UWF retinal mosaic.
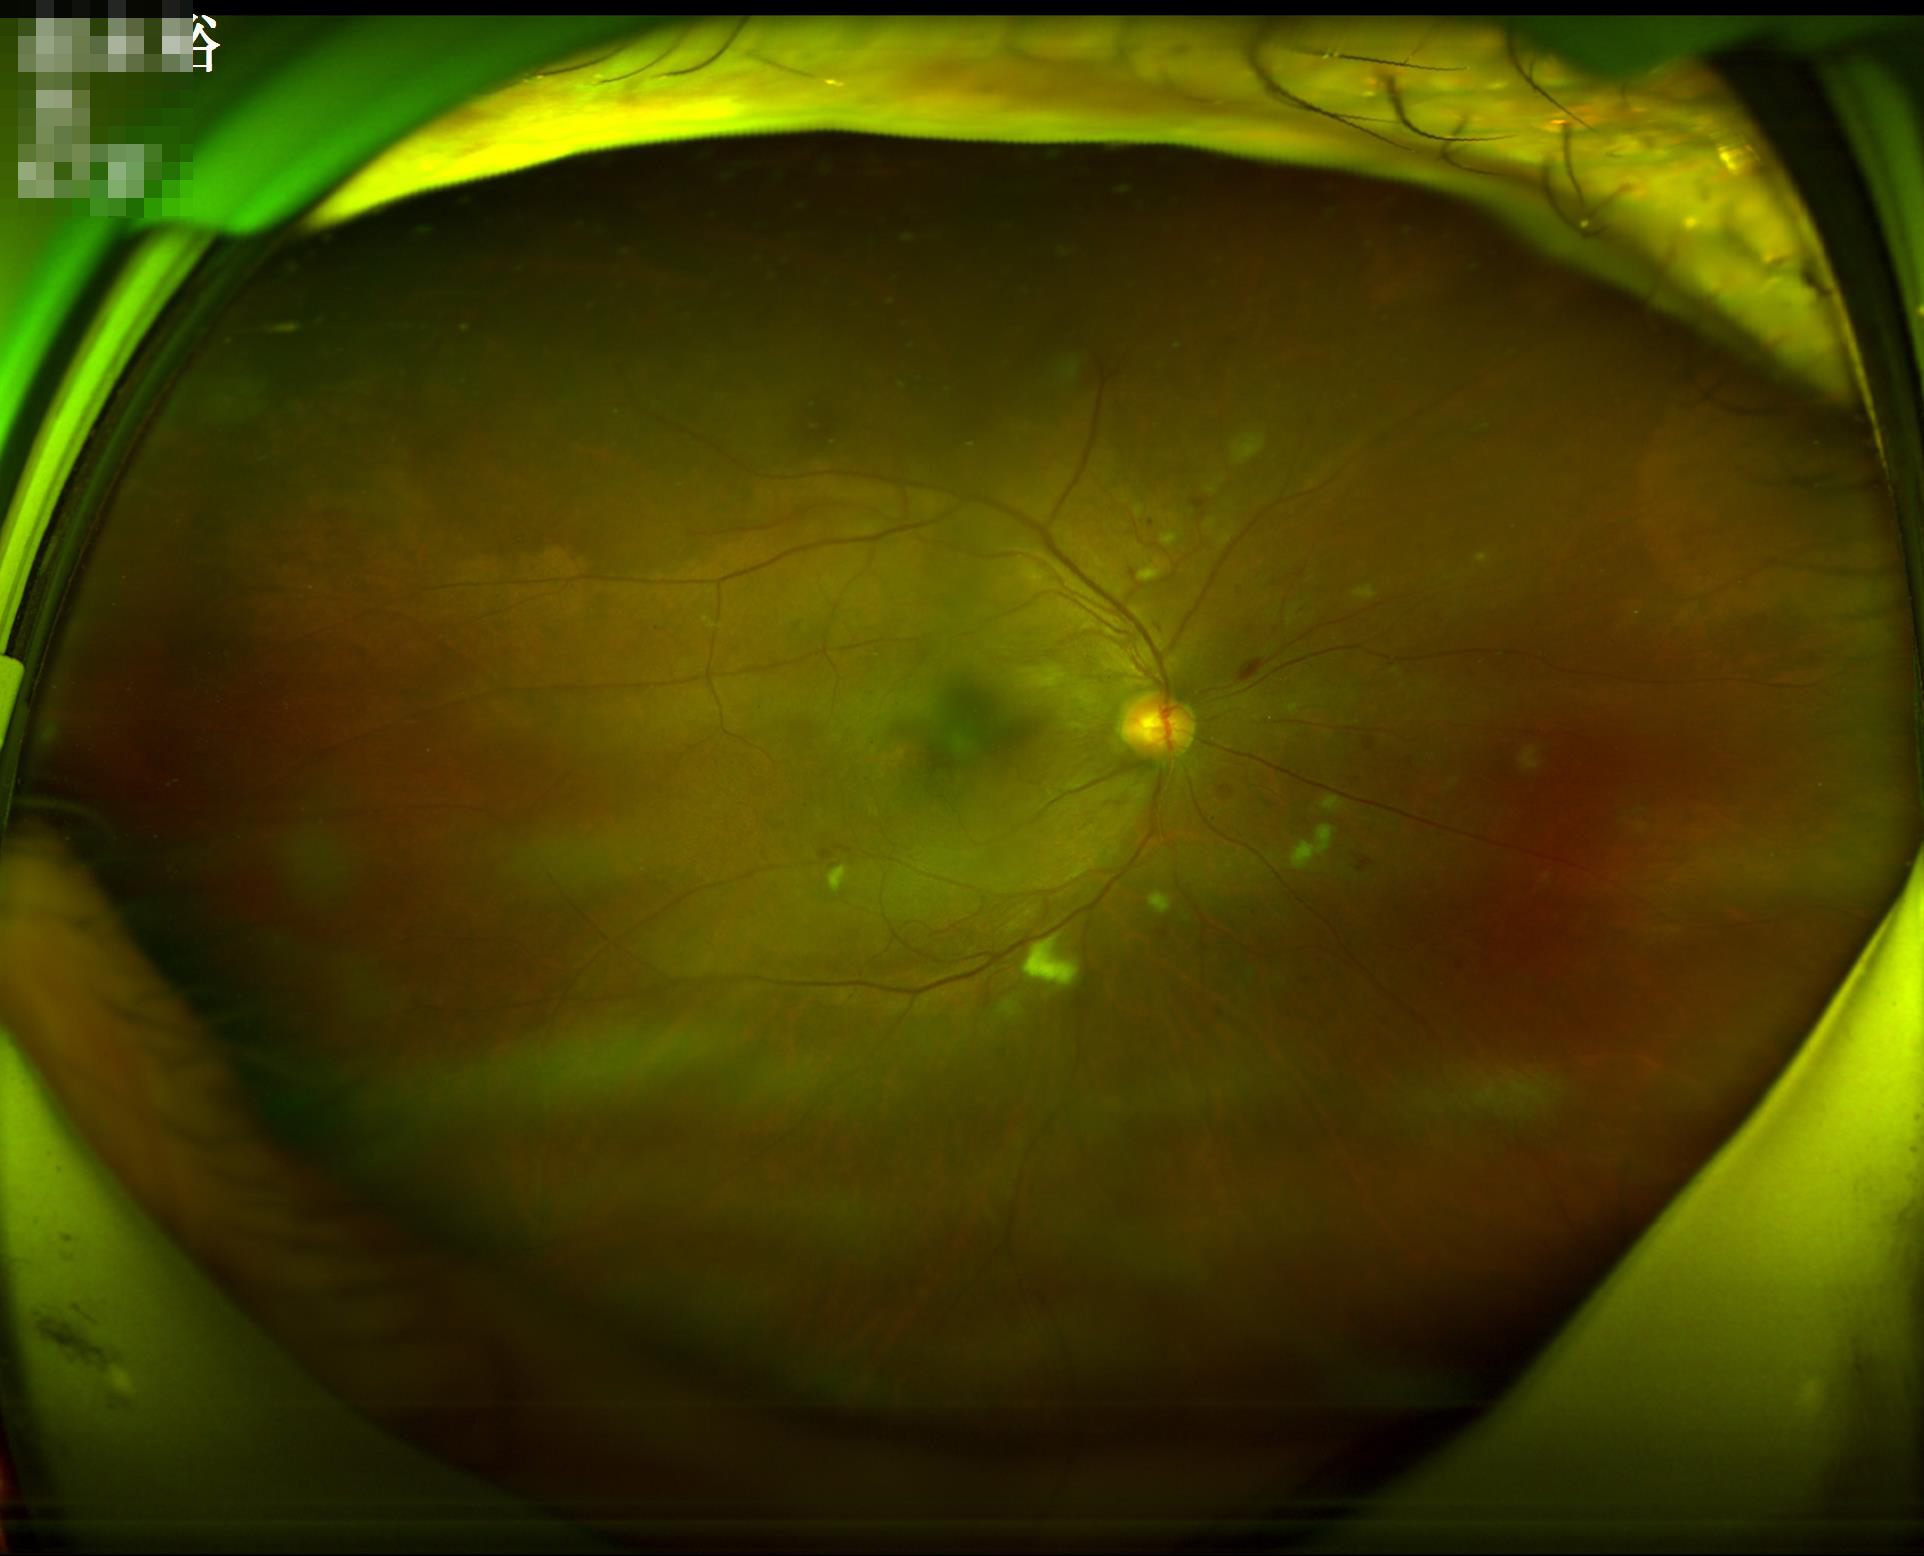 Vessels and details are readily distinguishable. Reduced sharpness with visible blur. Illumination is even. Overall image quality is good.